2352 x 1568 pixels; fundus photo; 45° field of view.
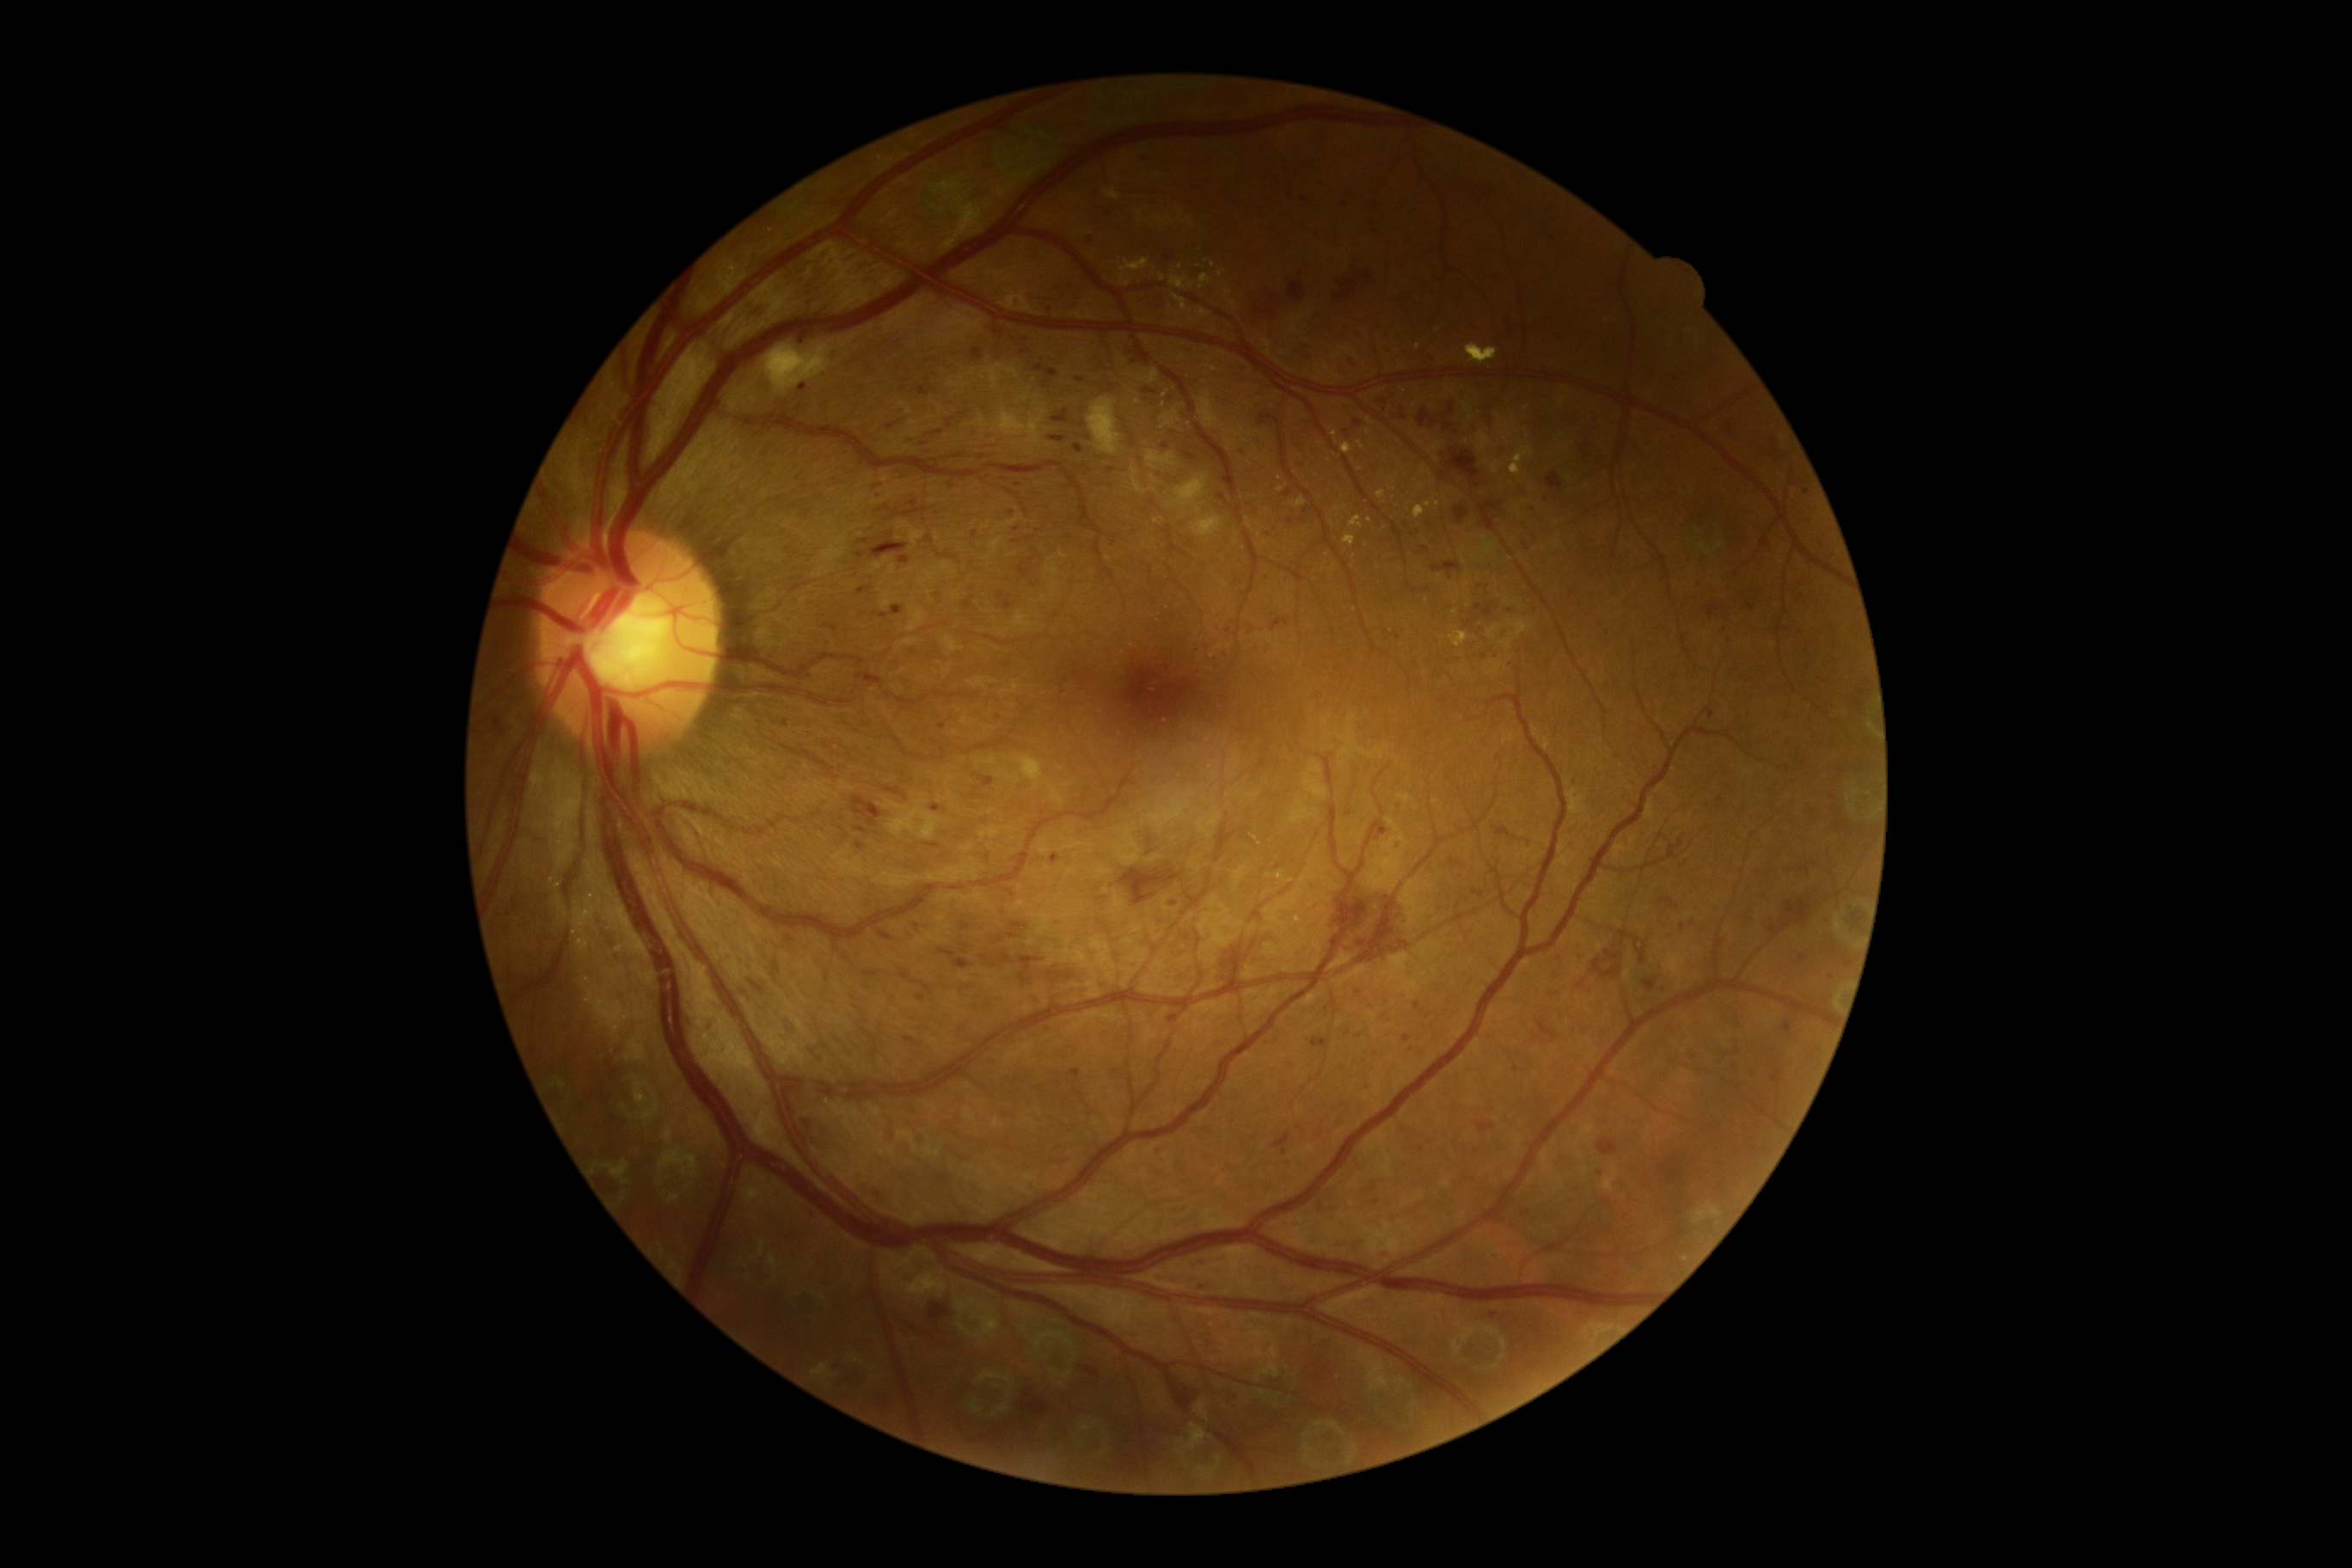 dr_grade: grade 3